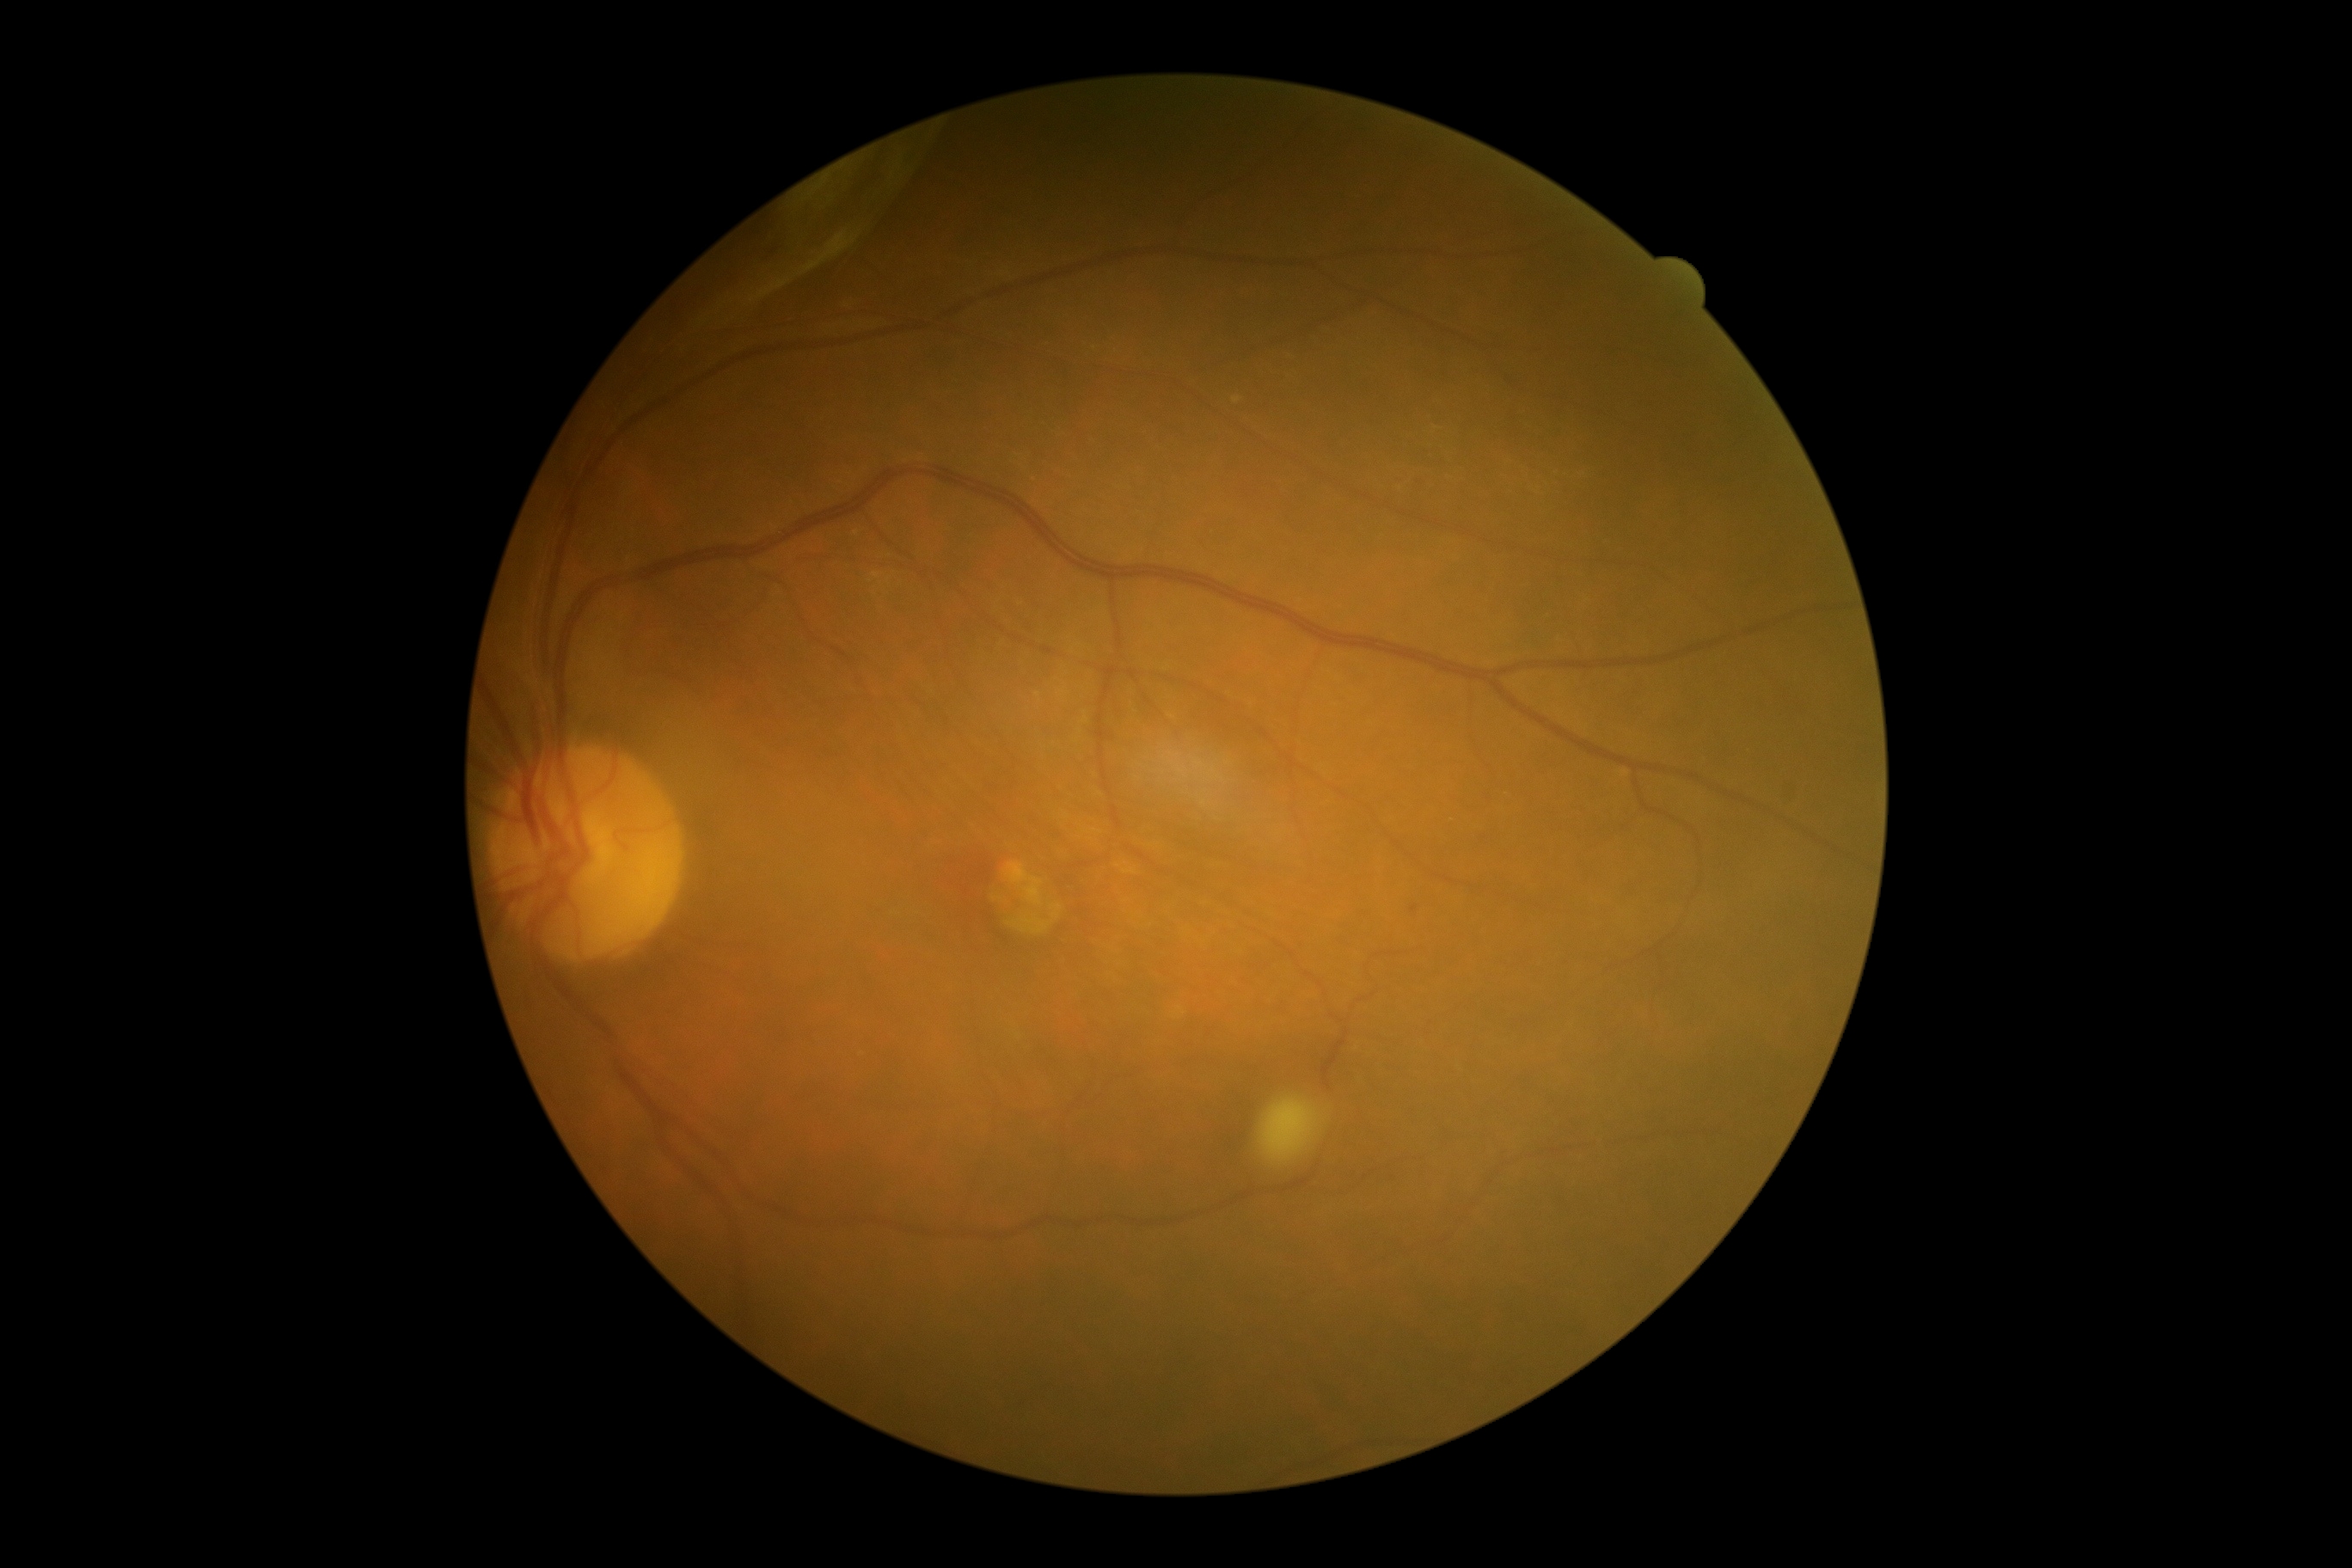

DR stage=4/4.